Nonmydriatic fundus photograph, 848 x 848 pixels
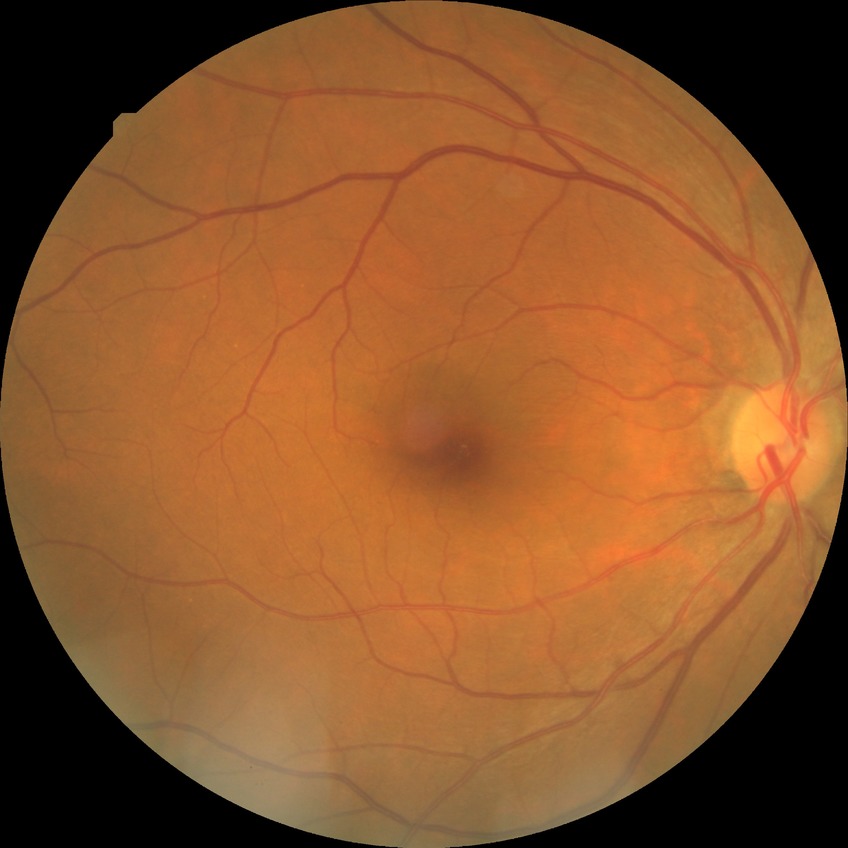 DR severity is NDR.